Color fundus photograph · 45° field of view — 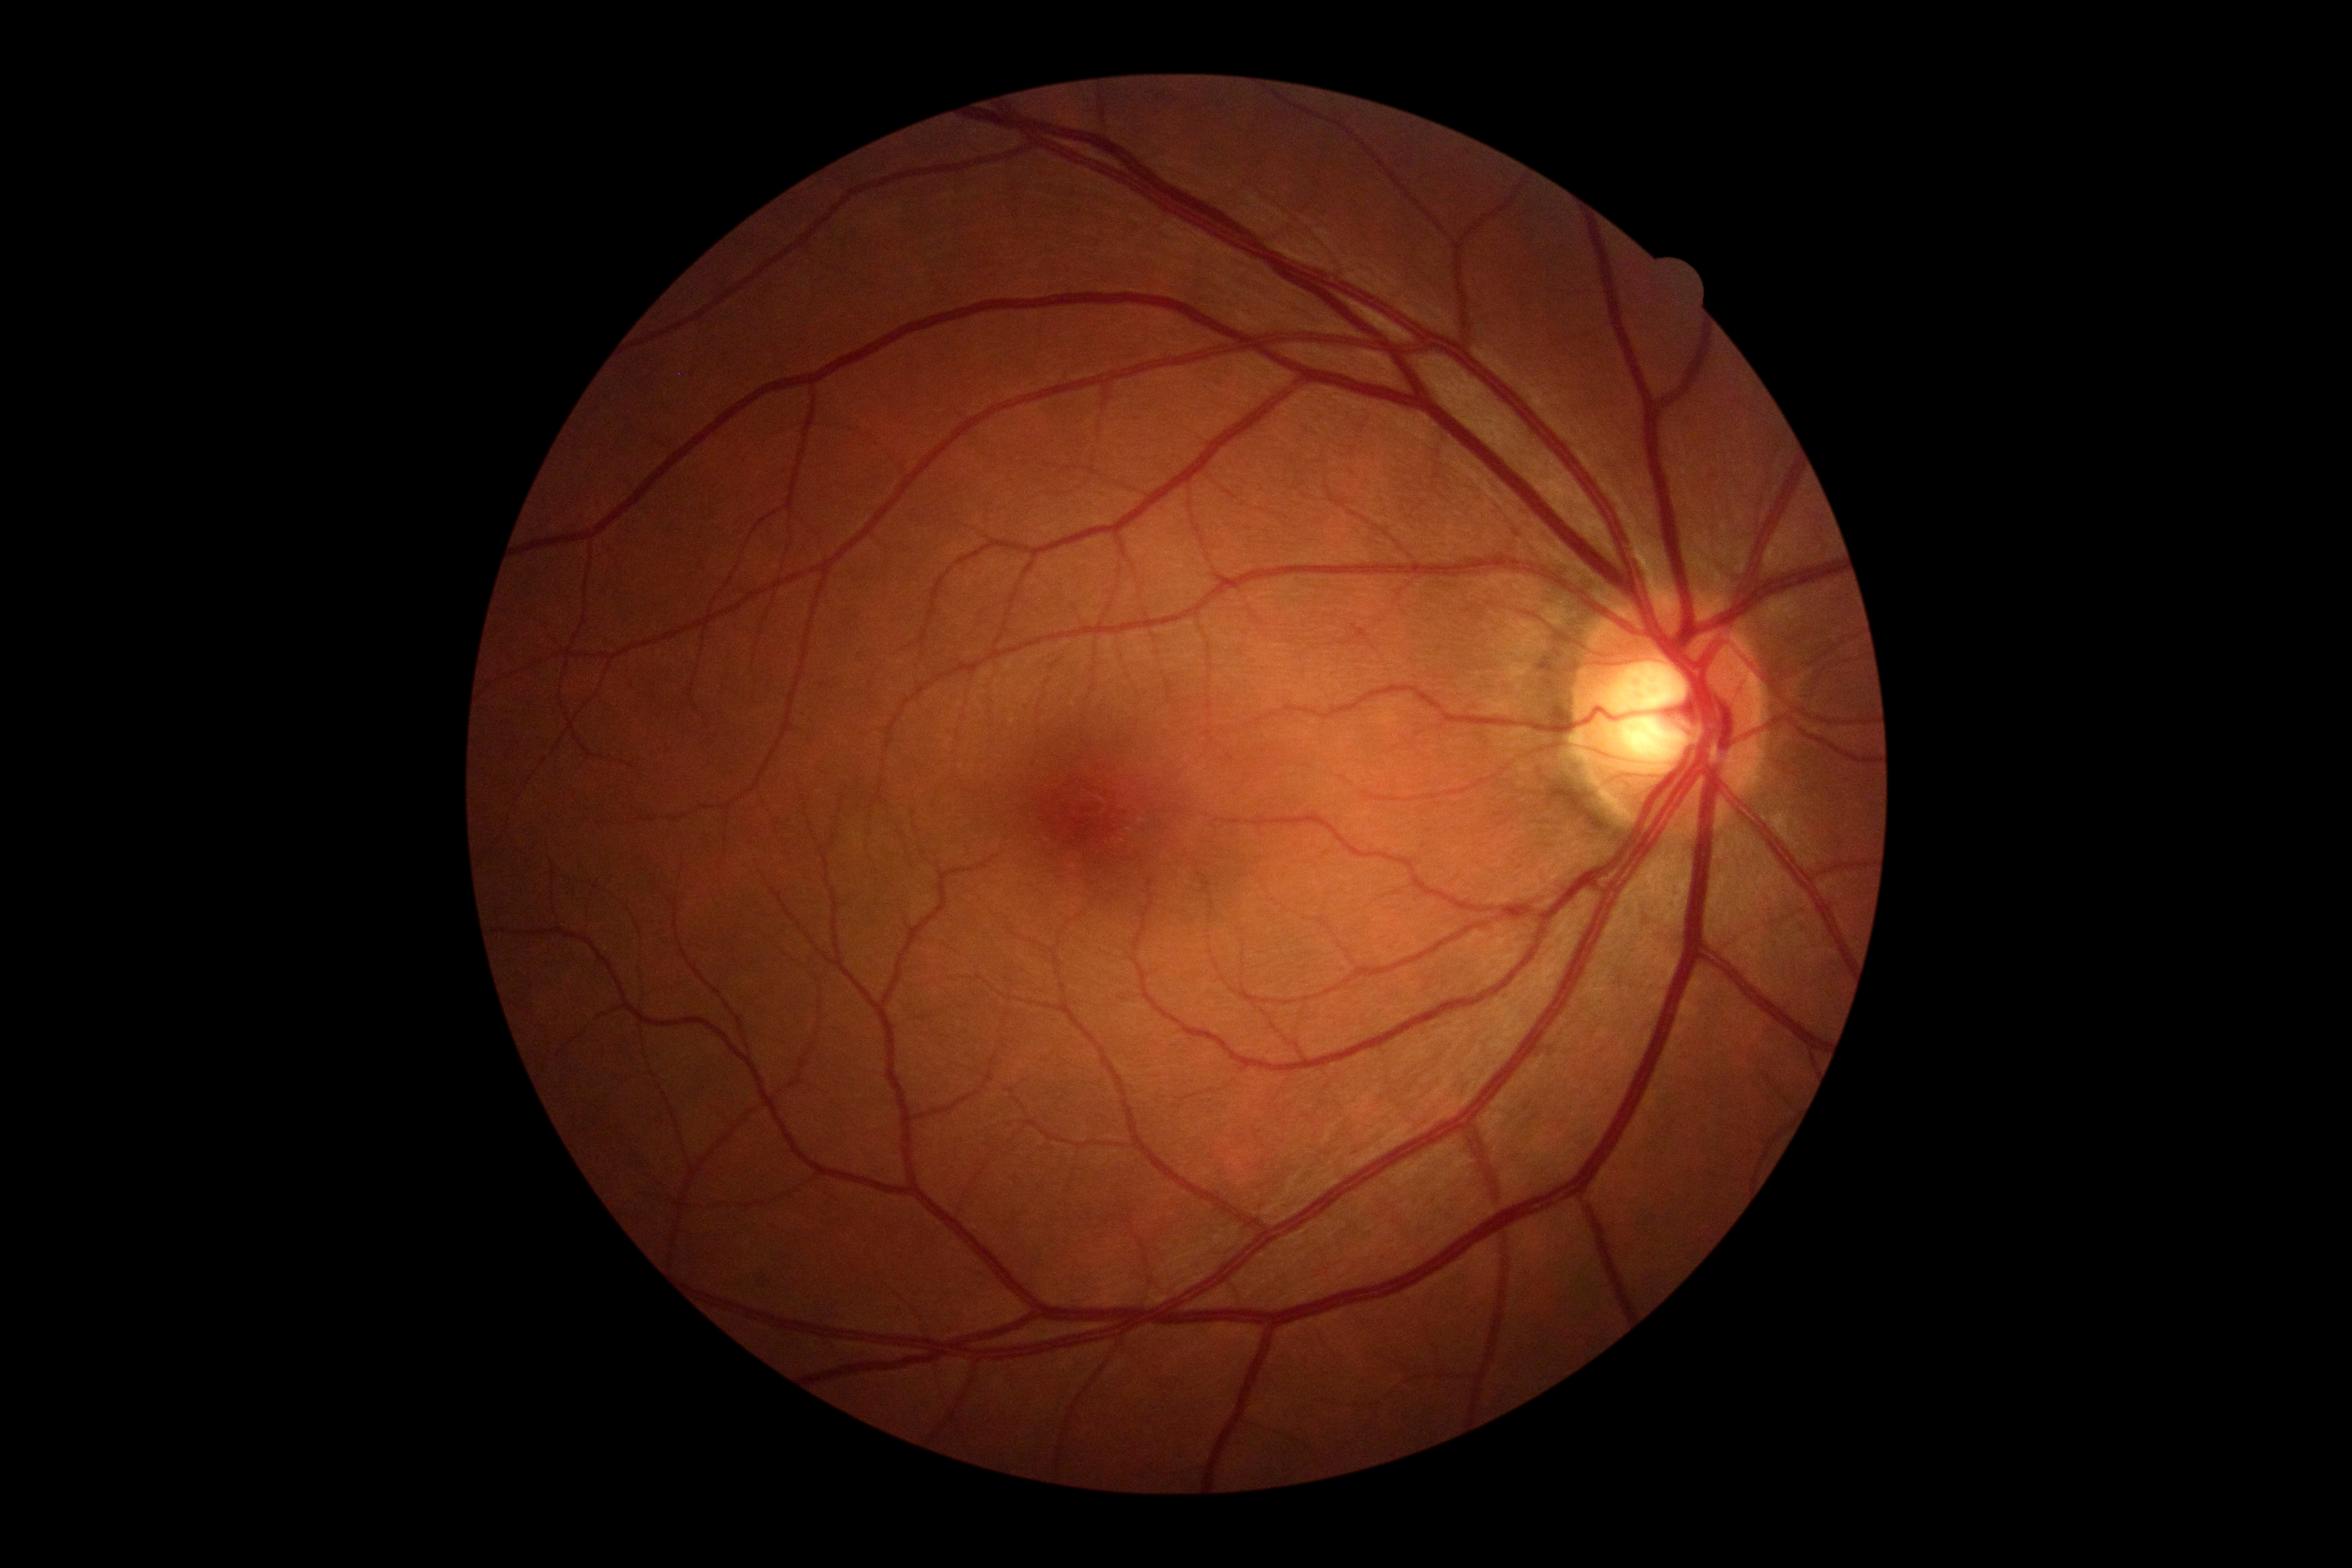

– diabetic retinopathy (DR): 0/4
– DR impression: no signs of DR